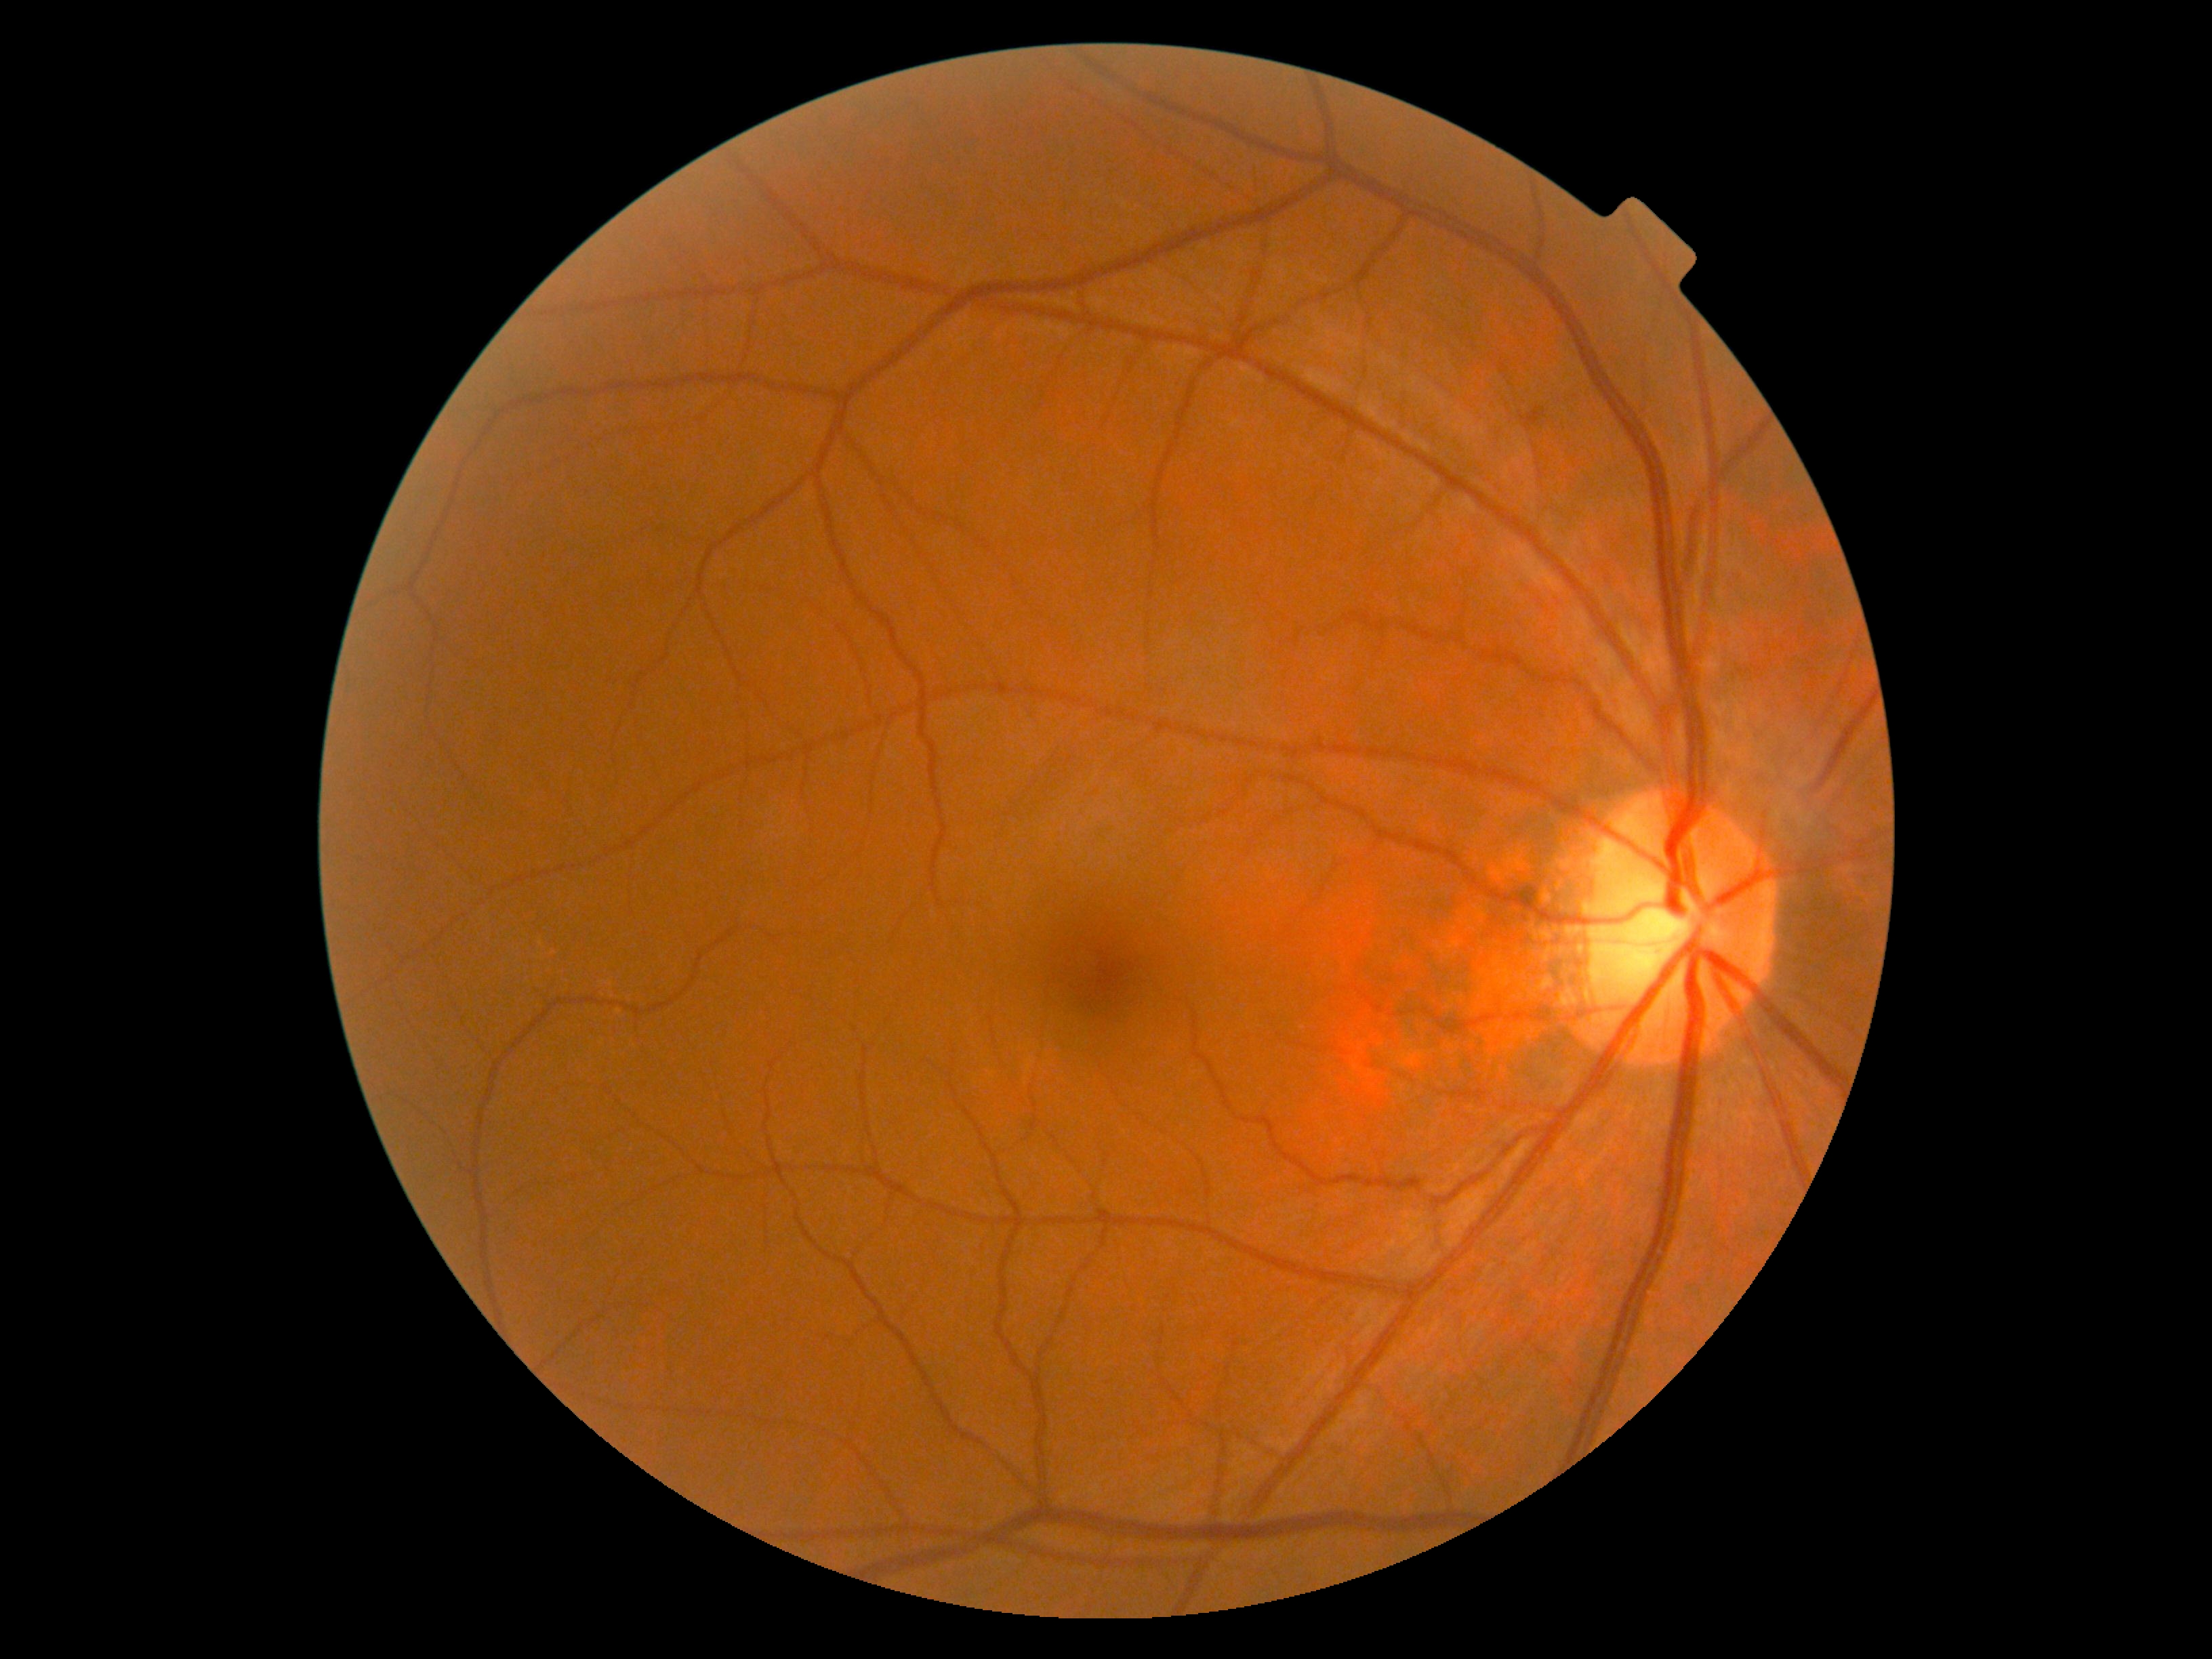 Retinopathy: 0/4. No signs of diabetic retinopathy.